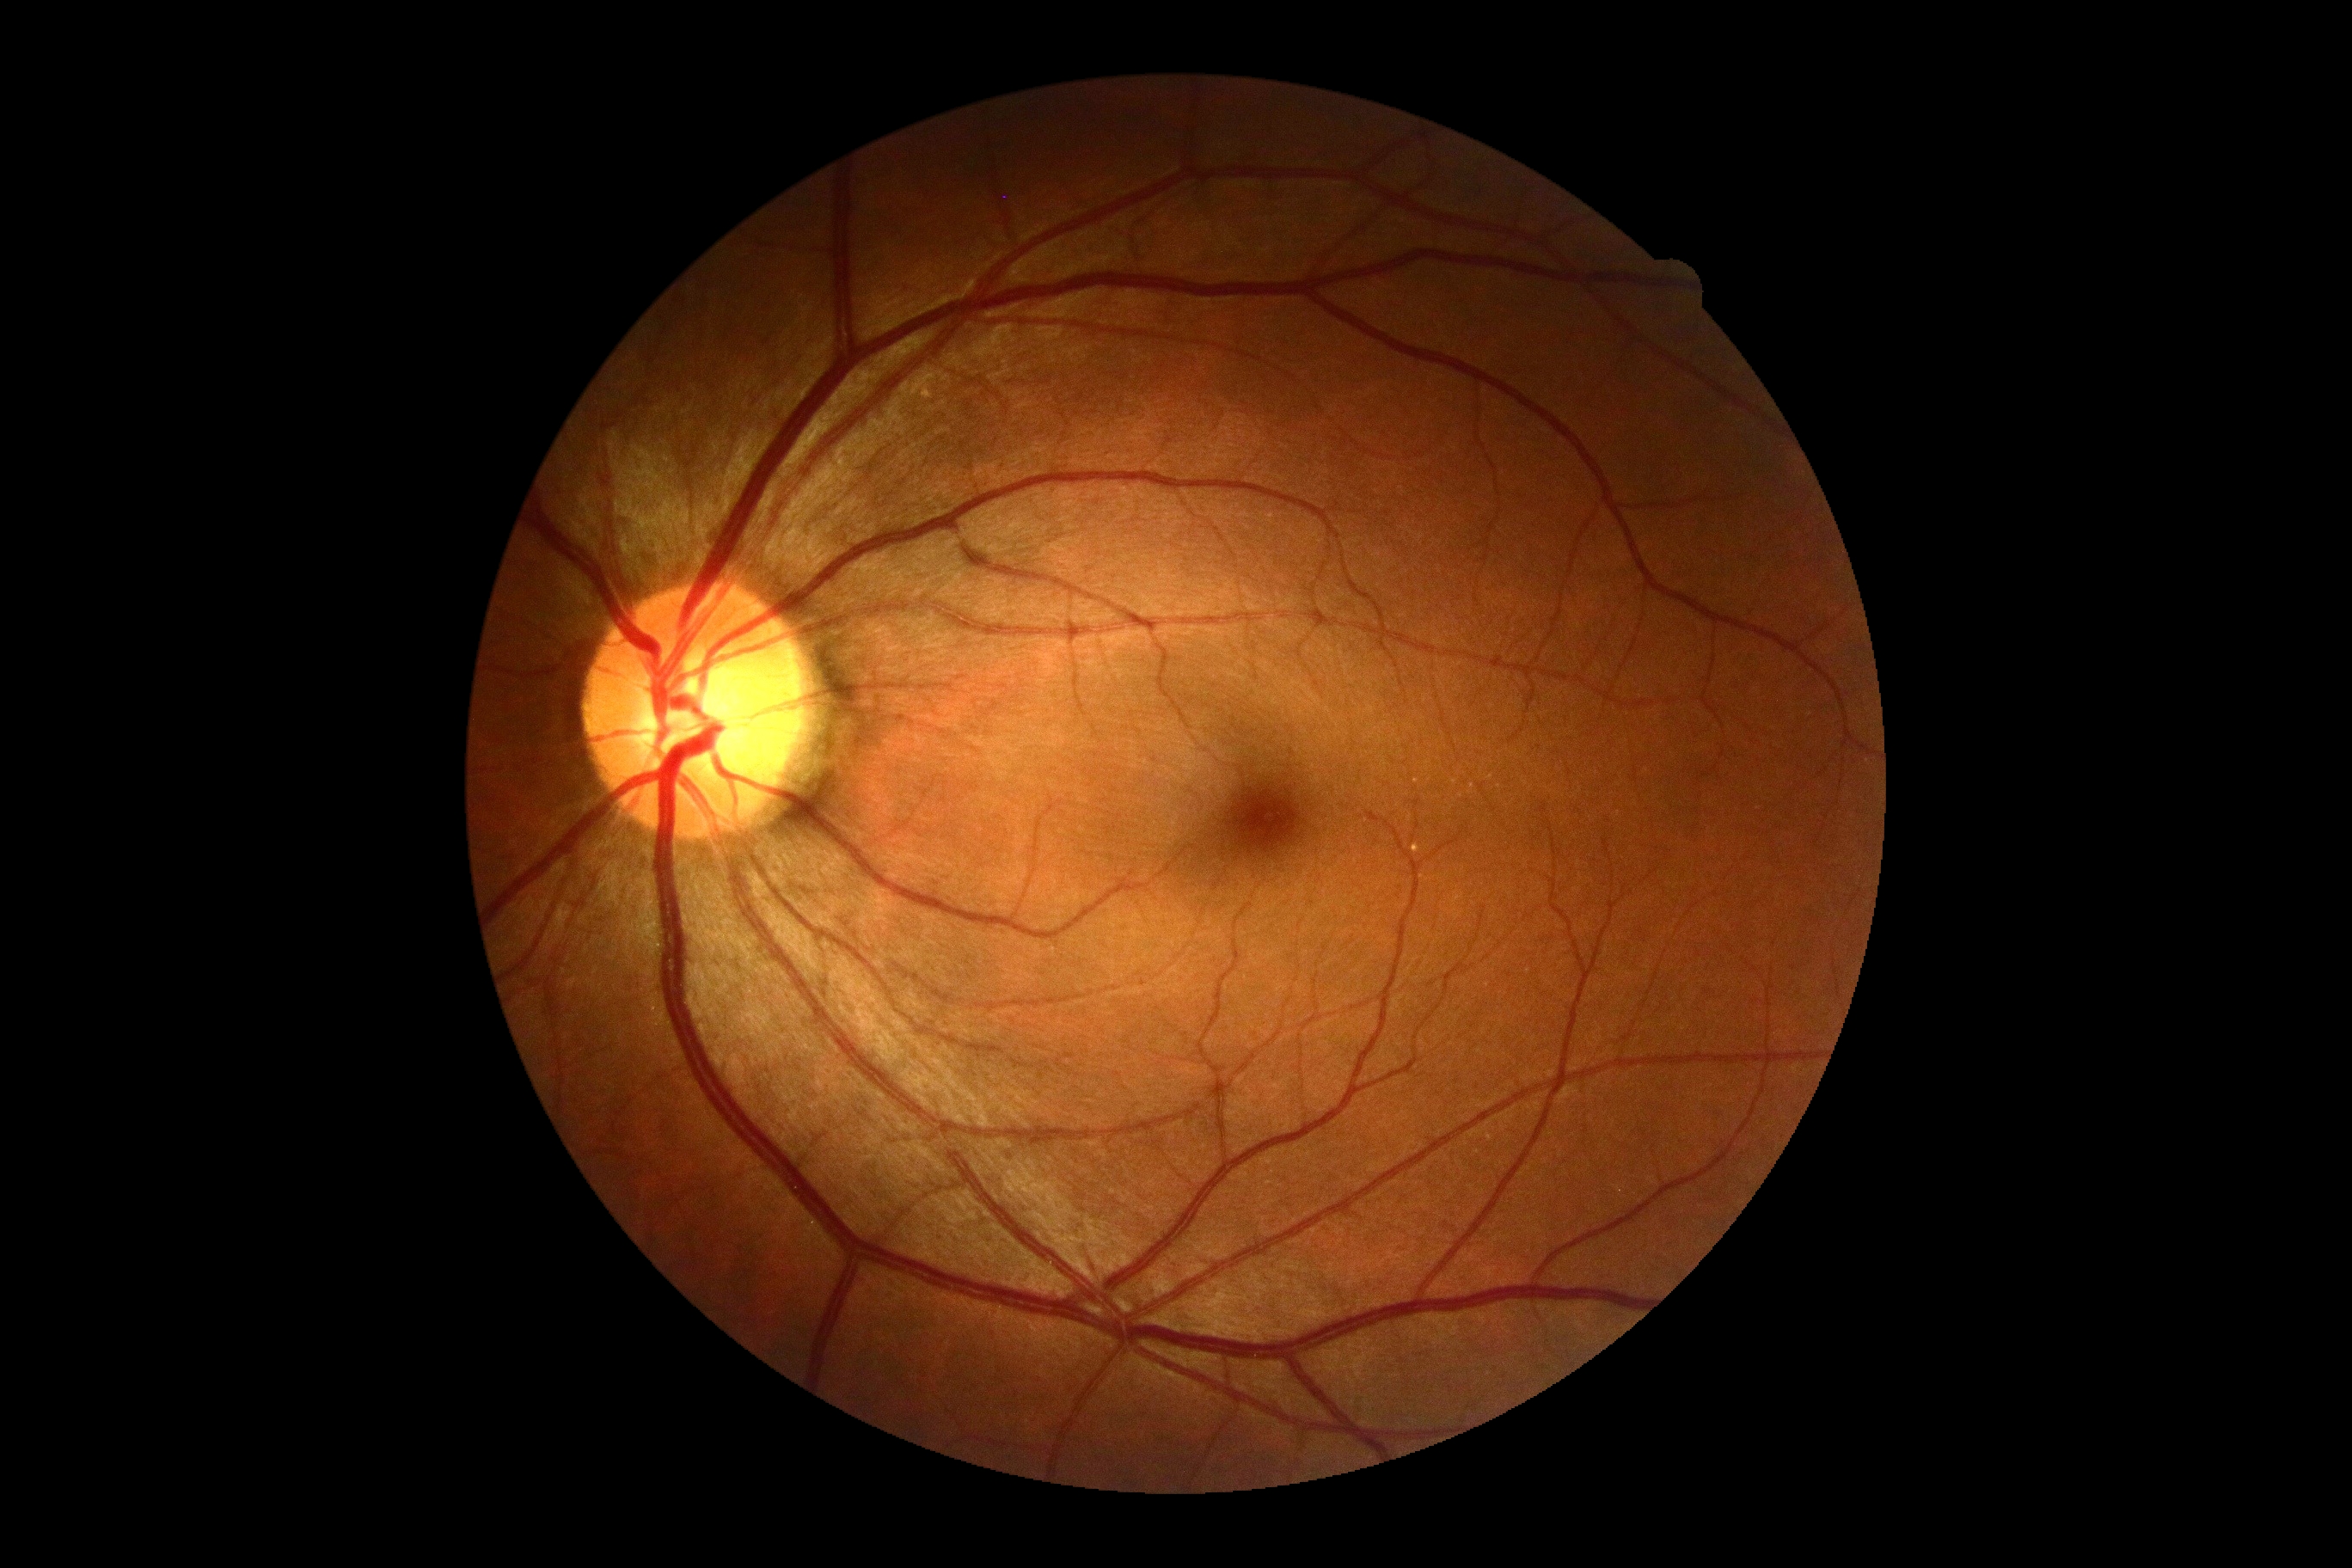
No signs of diabetic retinopathy. DR stage: 0/4.